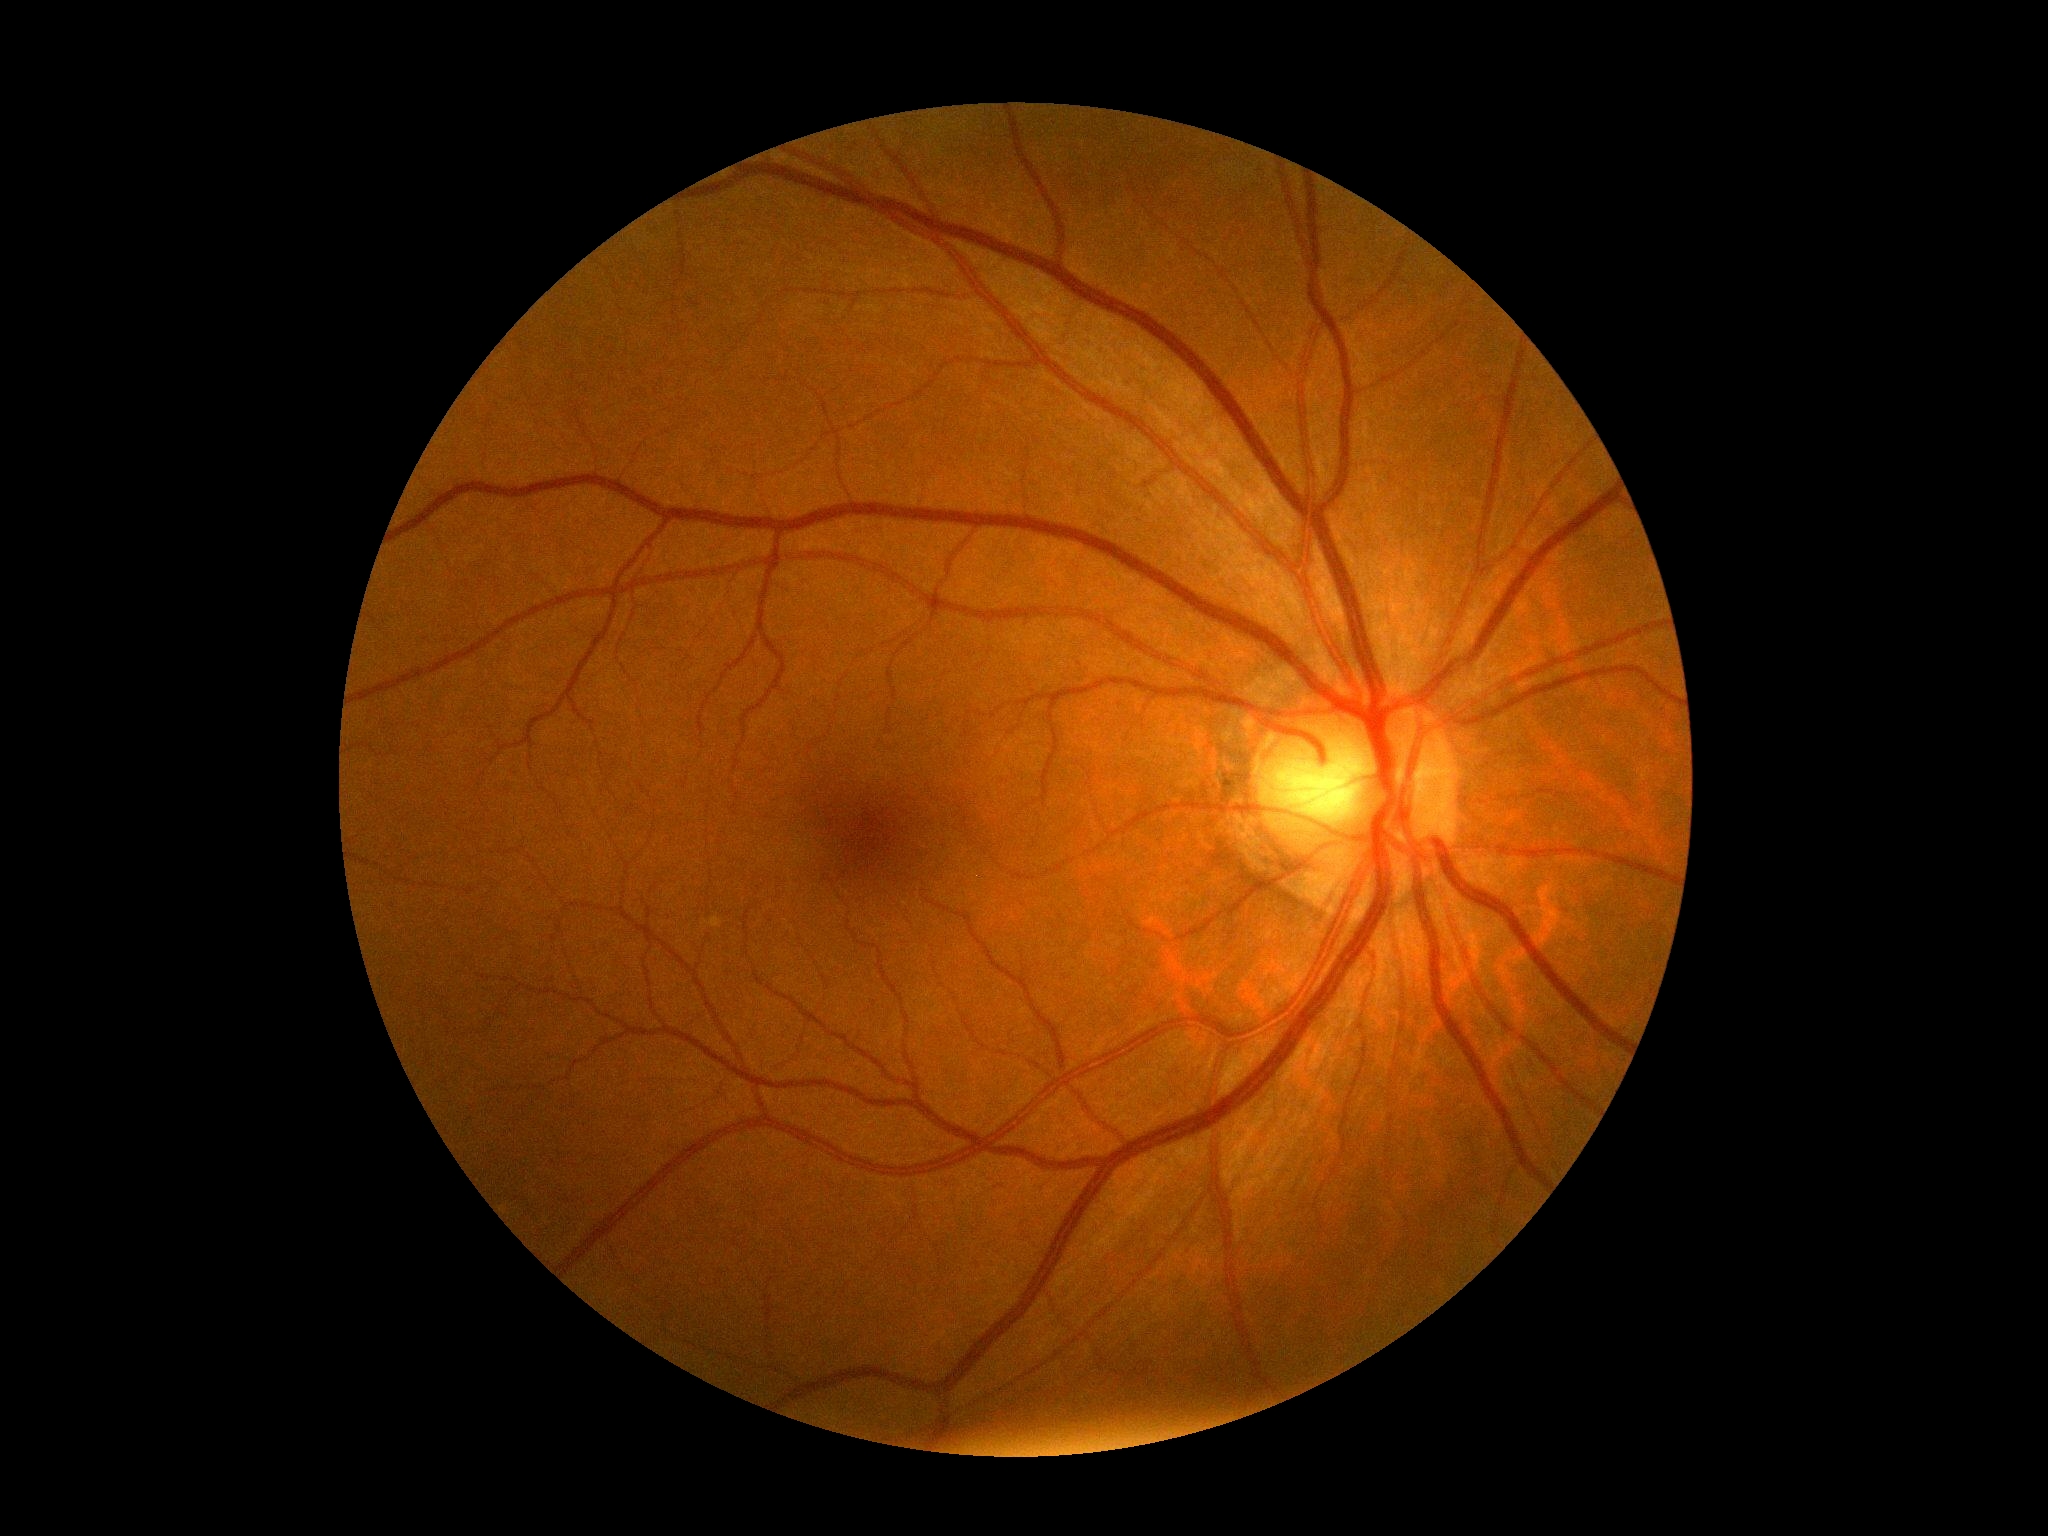 DR severity = grade 0.